50° FOV. Camera: Topcon TRC-NW8:
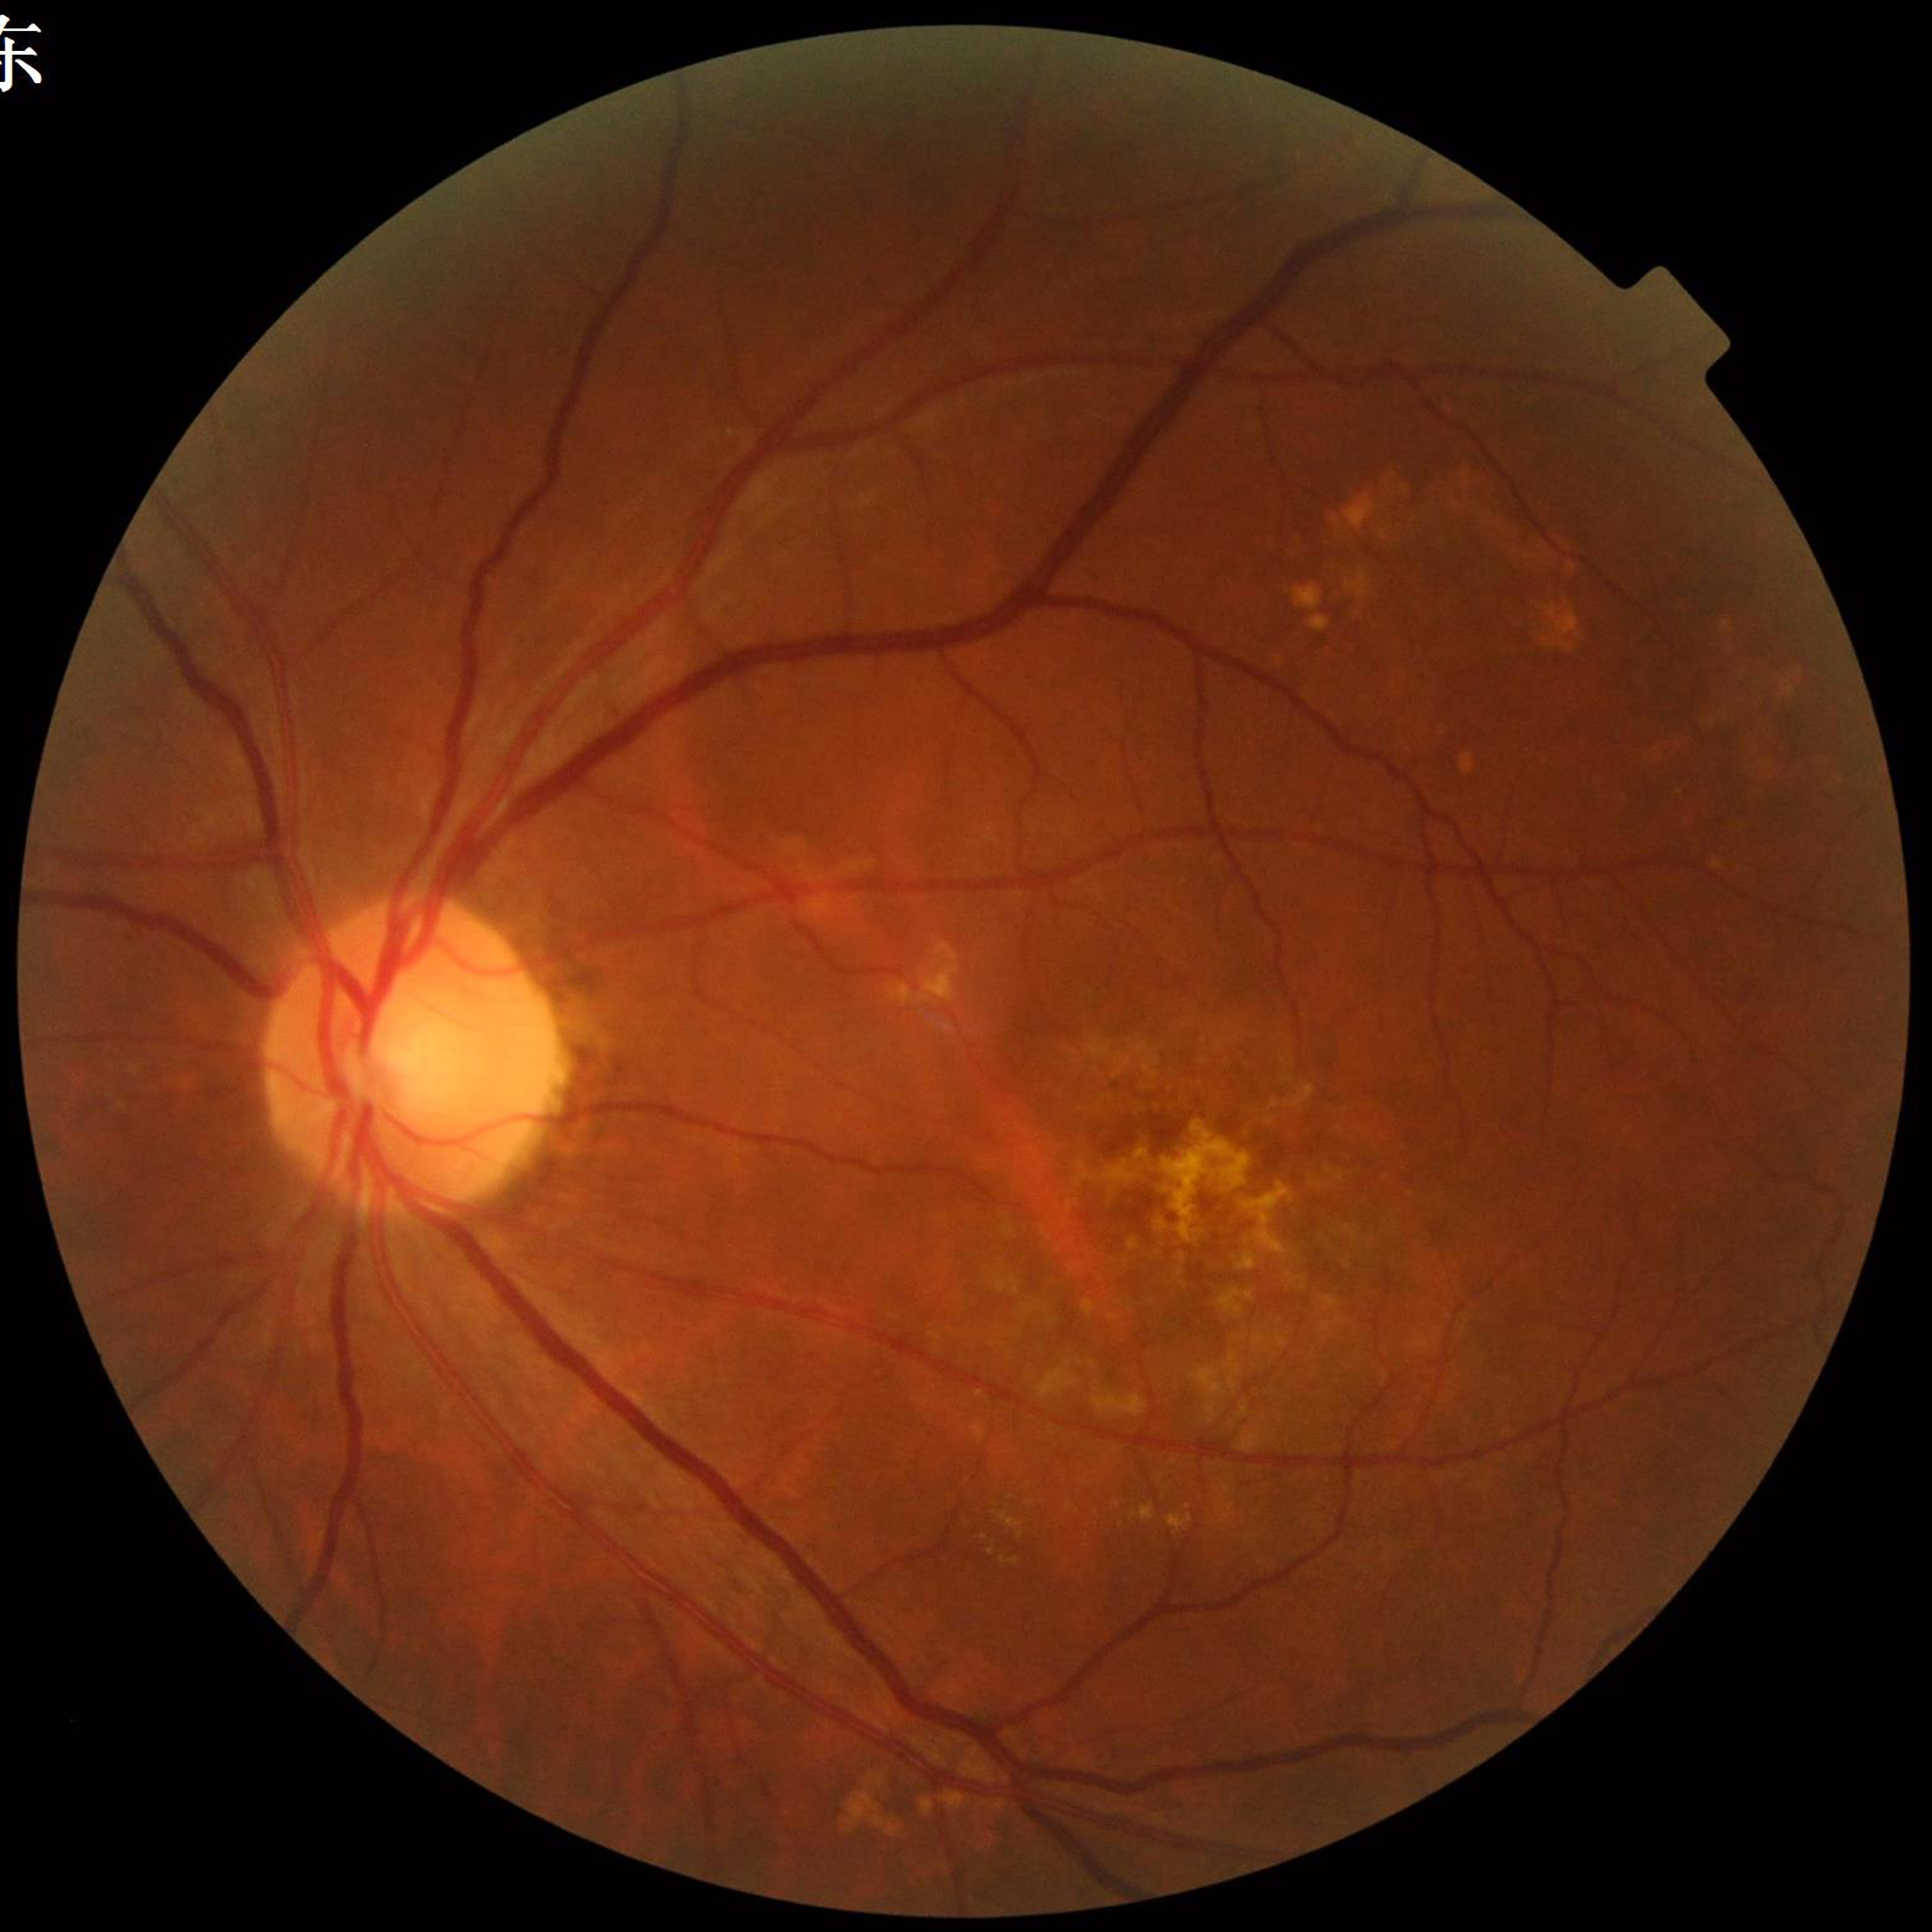

Image quality: good. The patient was diagnosed with AMD.